45° field of view · color fundus photograph · image size 2048x1536:
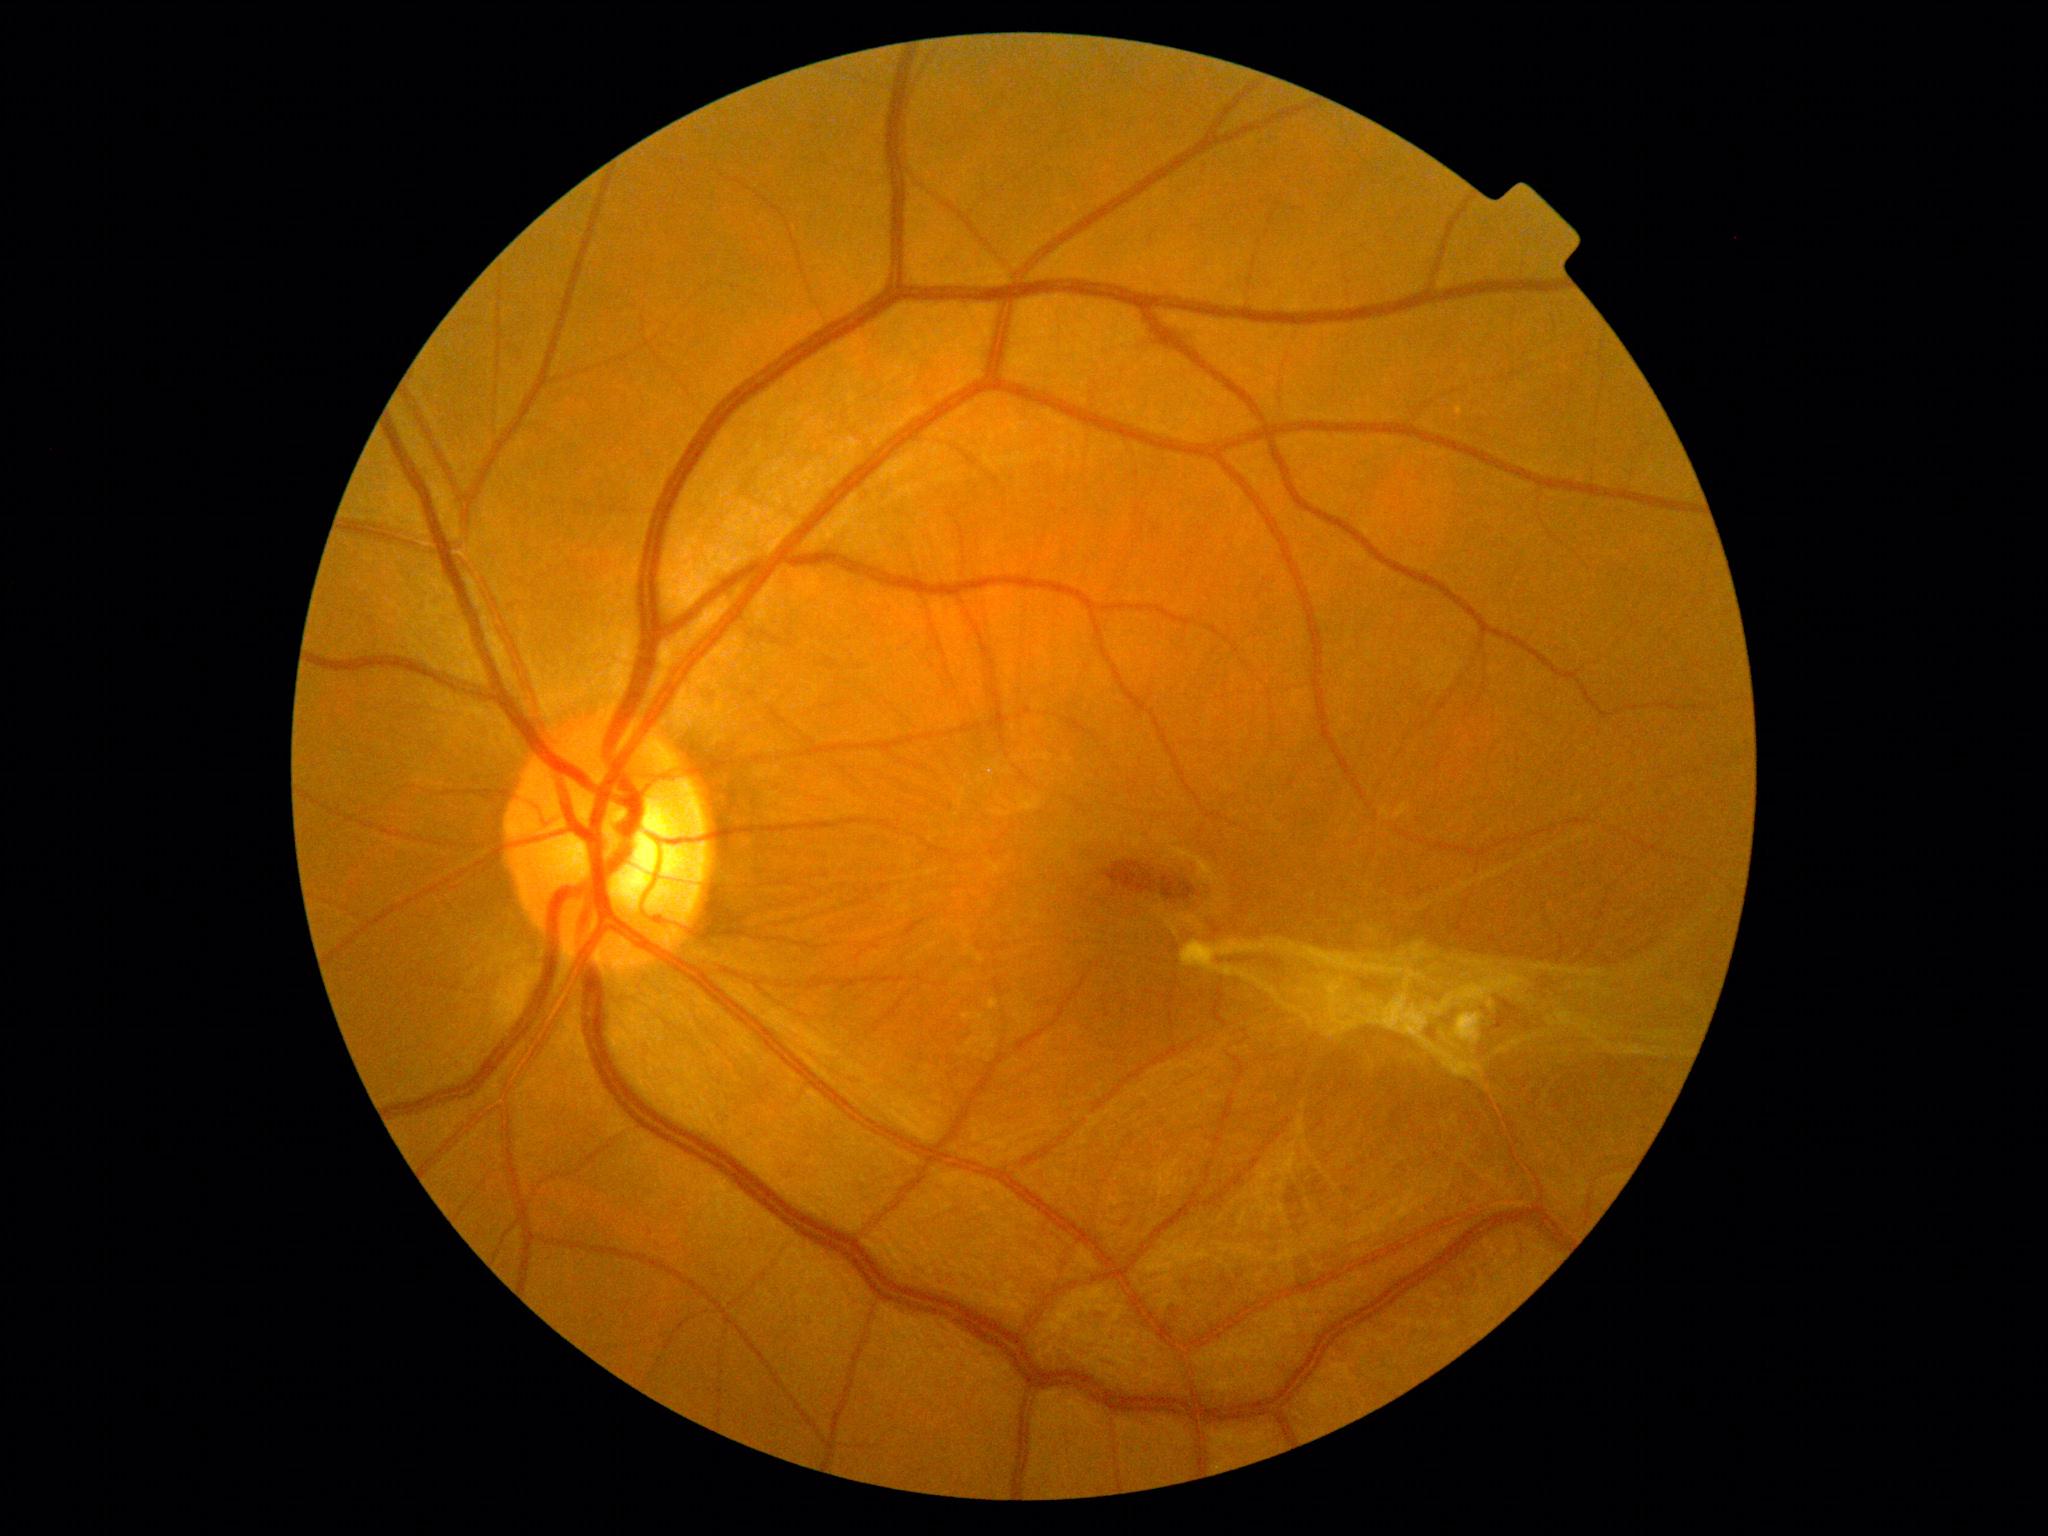
DR grade is 4 (PDR).
DR class: proliferative diabetic retinopathy.